Wide-field fundus image from infant ROP screening; 1440x1080px.
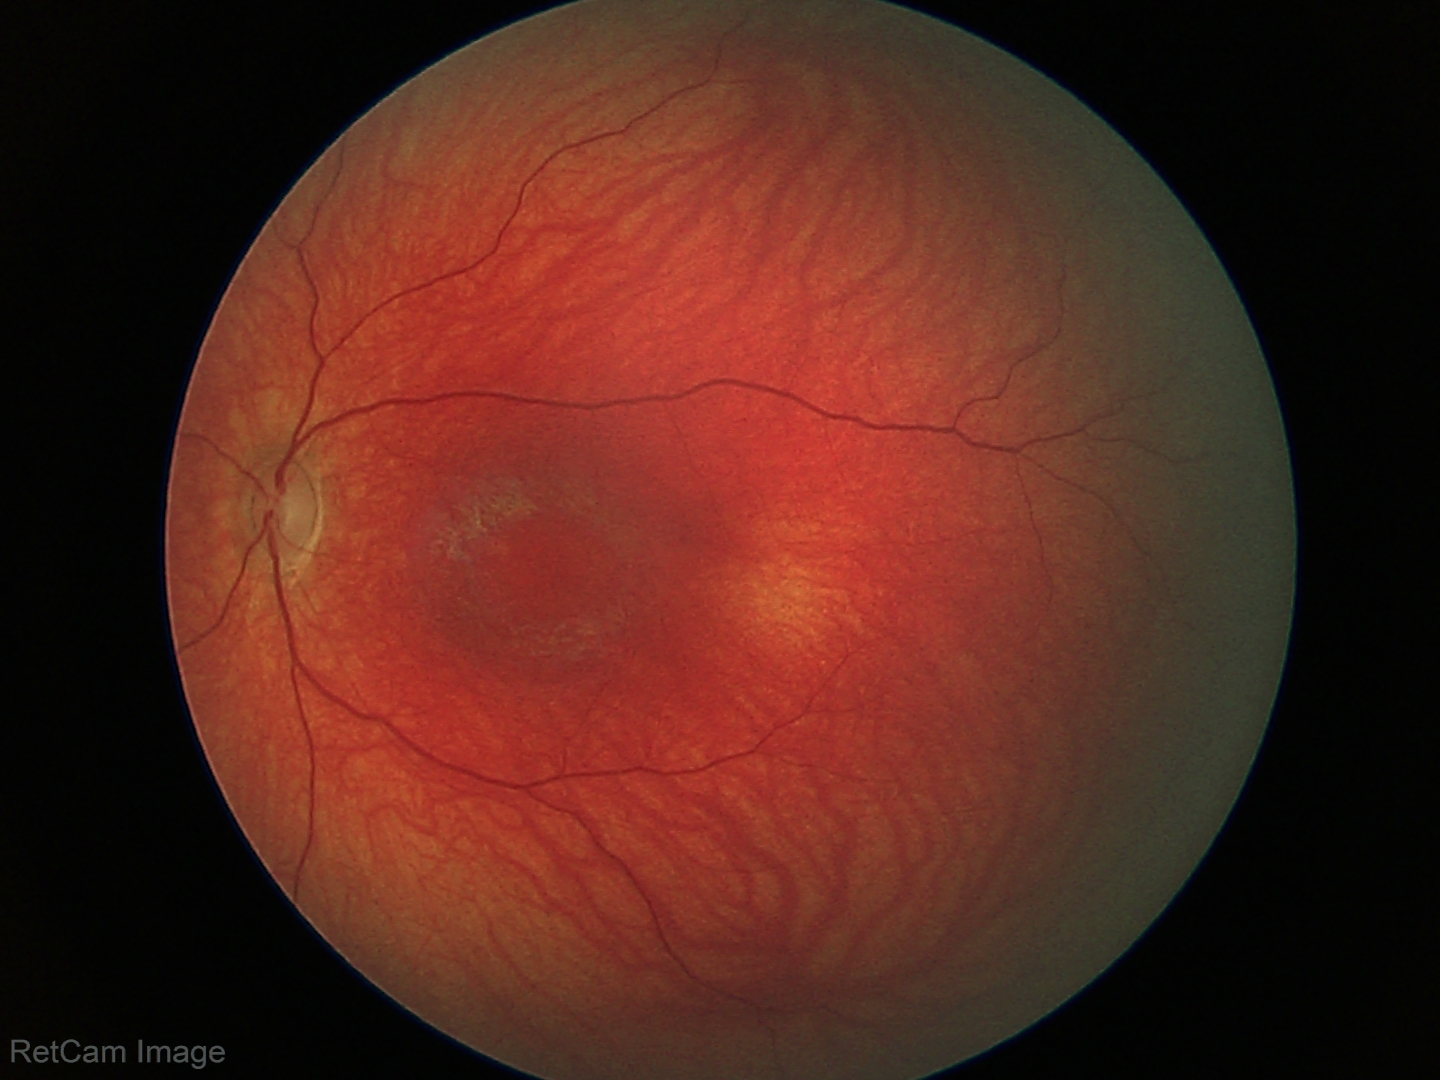 Impression = no pathology identified.